2212x1659, FOV: 45 degrees, retinal fundus photograph.
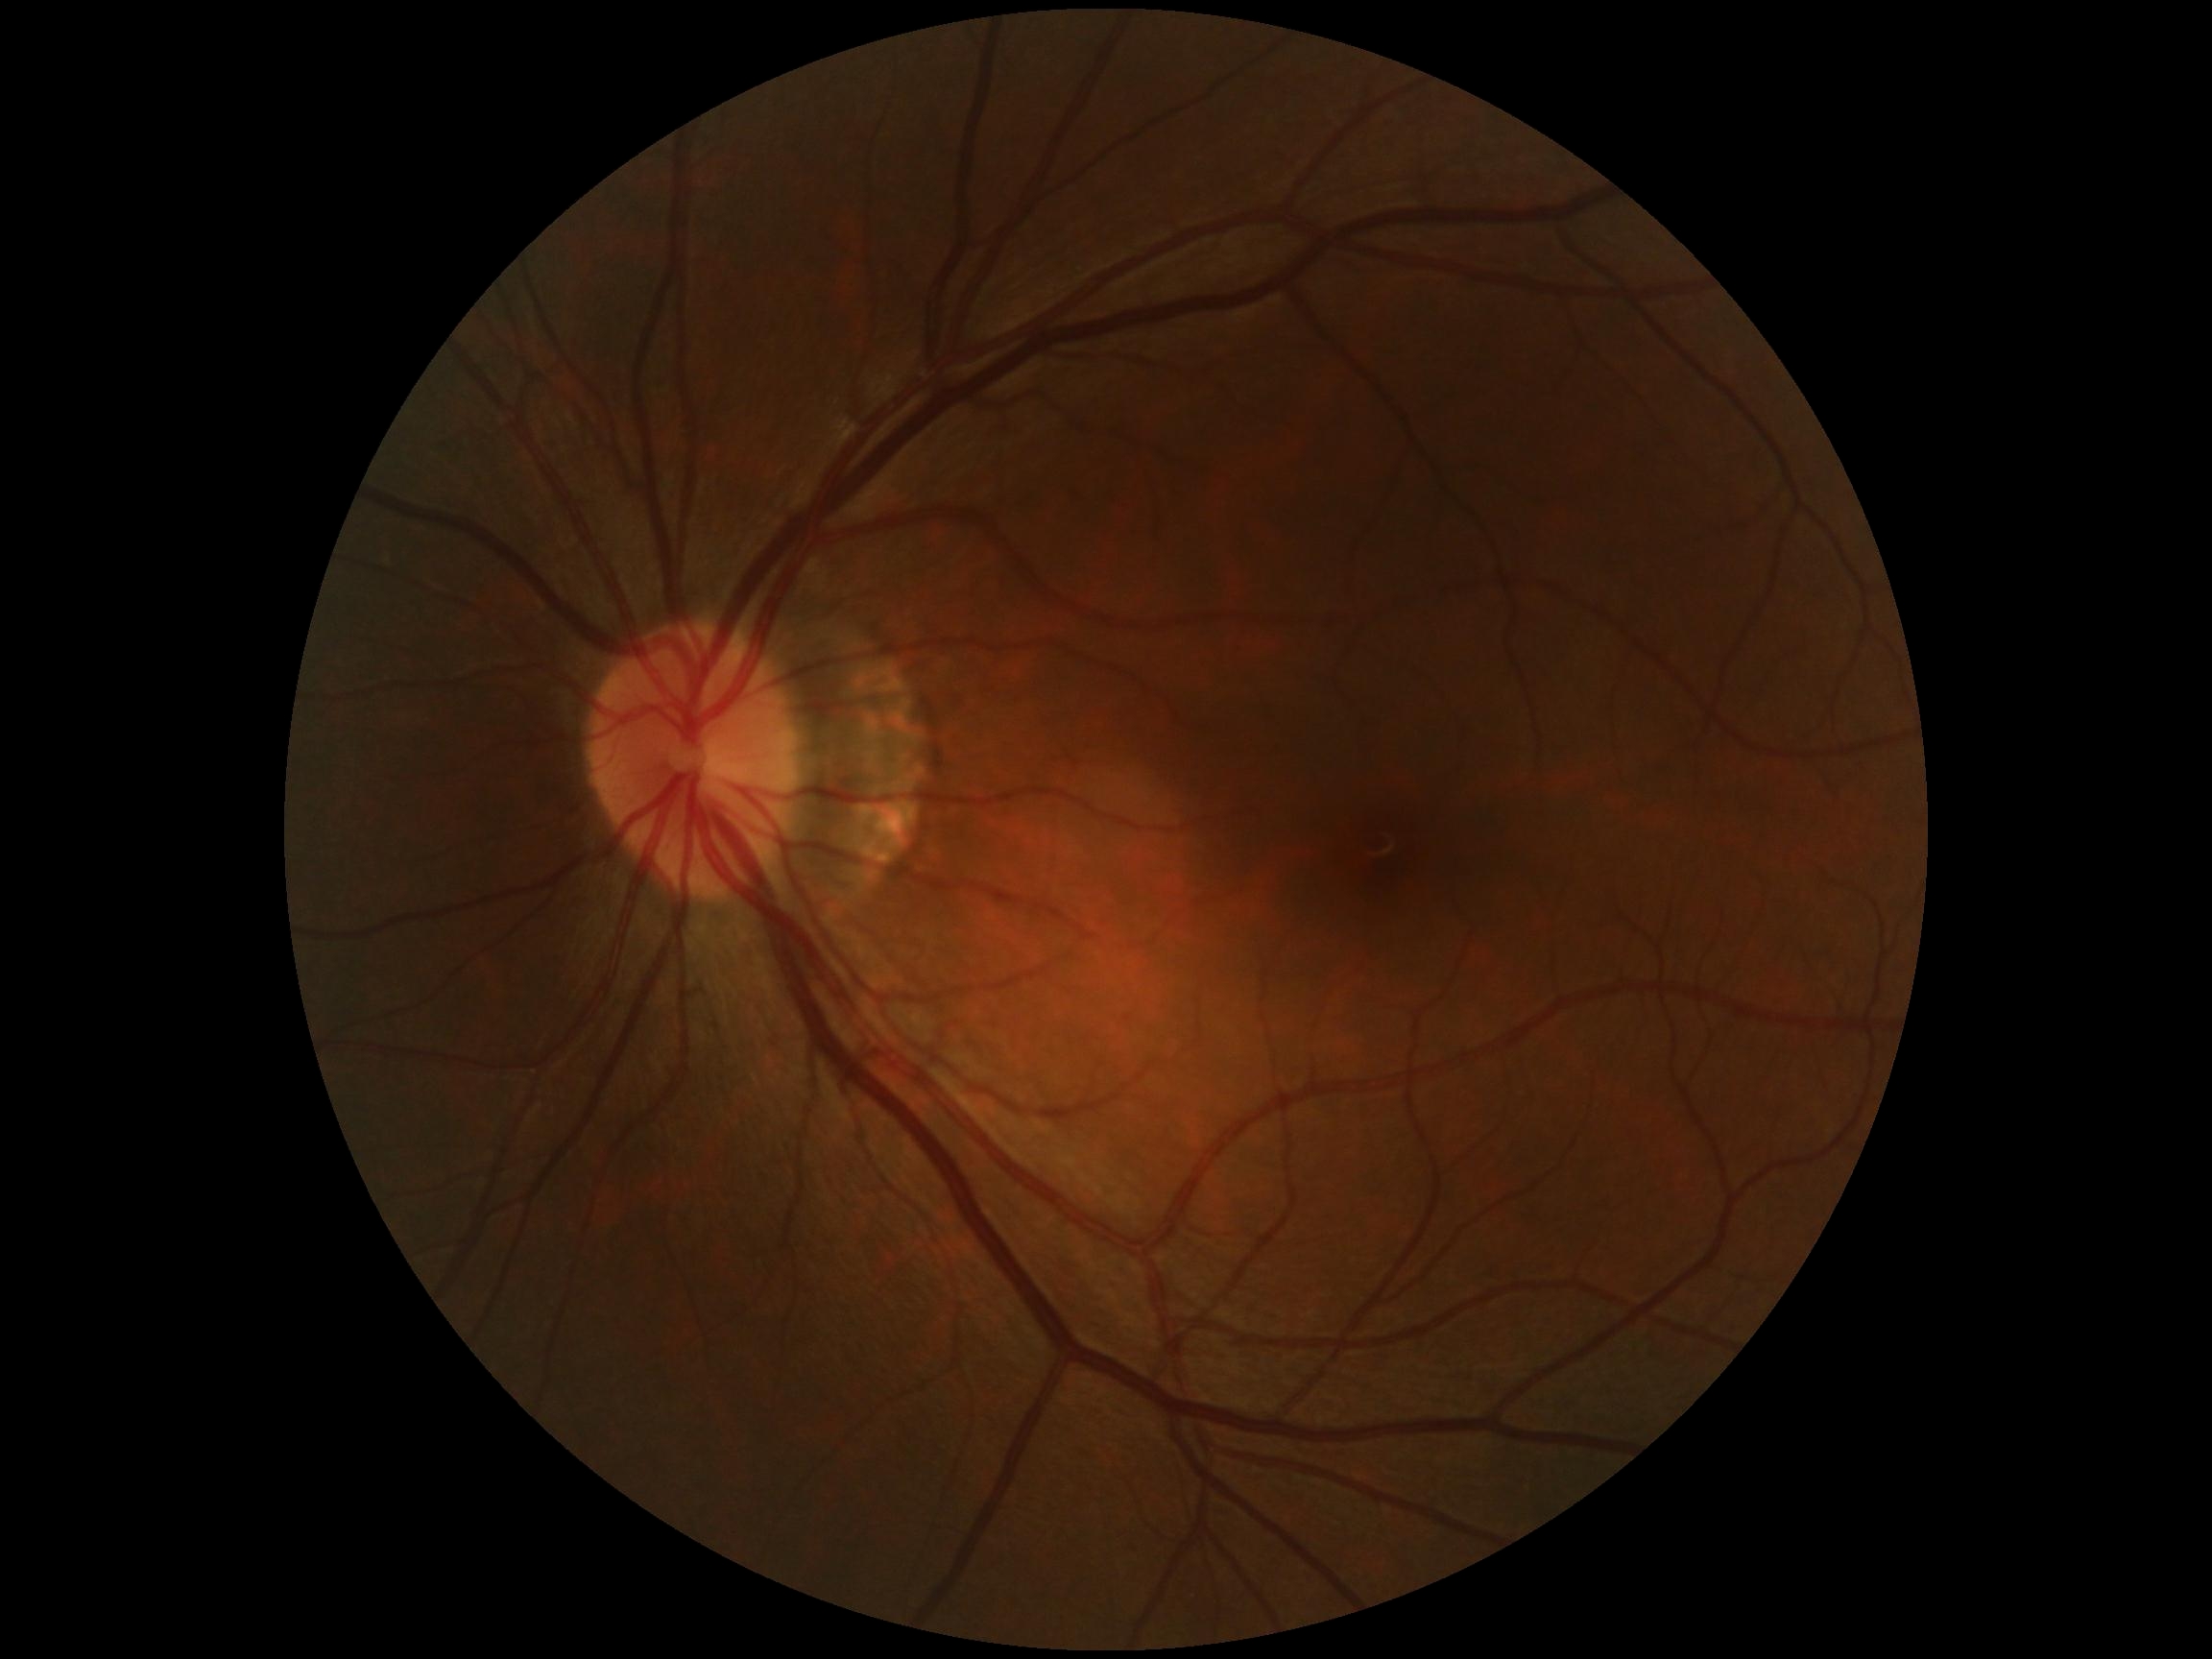

diabetic retinopathy (DR): grade 0 (no apparent retinopathy)